Captured with the Clarity RetCam 3 (130° field of view); 640 x 480 pixels; pediatric wide-field fundus photograph
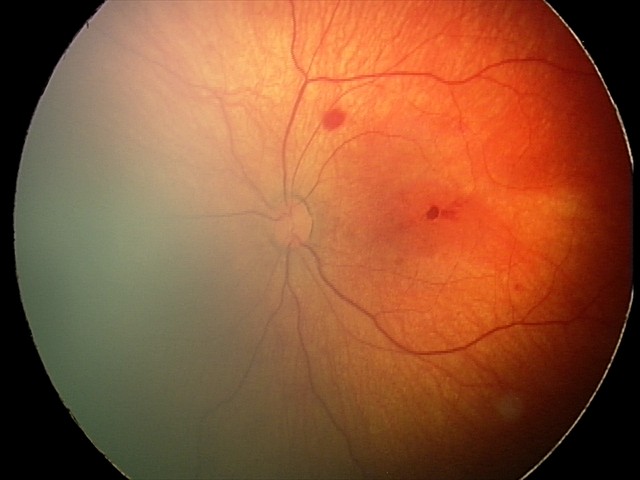

Screening series with retinal hemorrhages.